Wide-field retinal mosaic image: 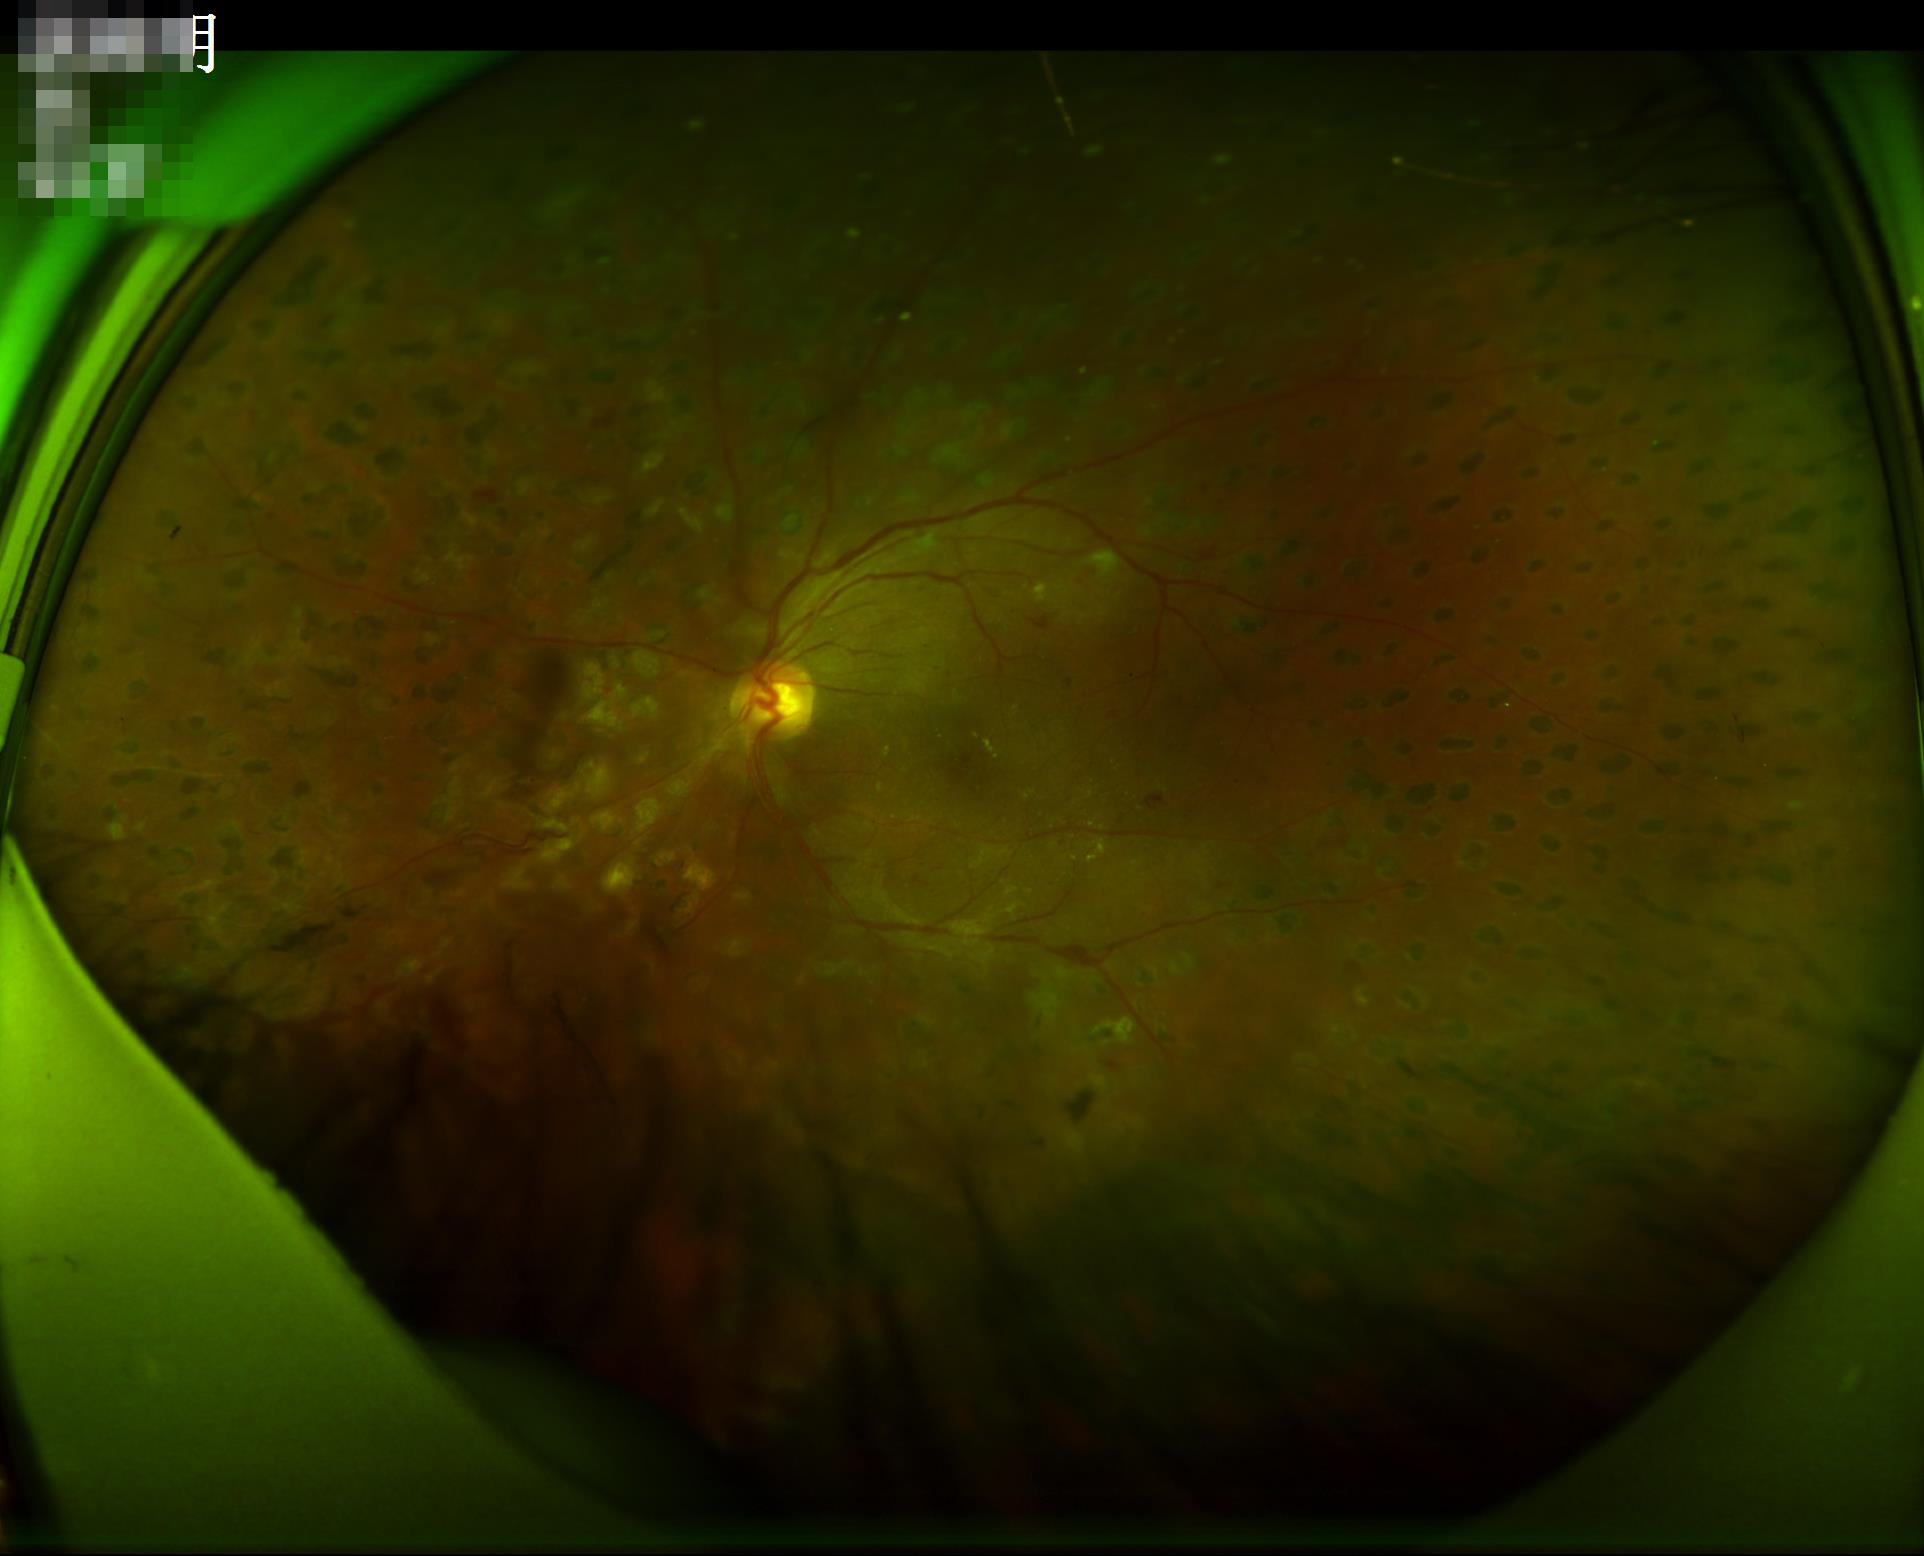

Poor illumination with uneven exposure. Adequate contrast for distinguishing structures. Acceptable image quality. The image is clear.